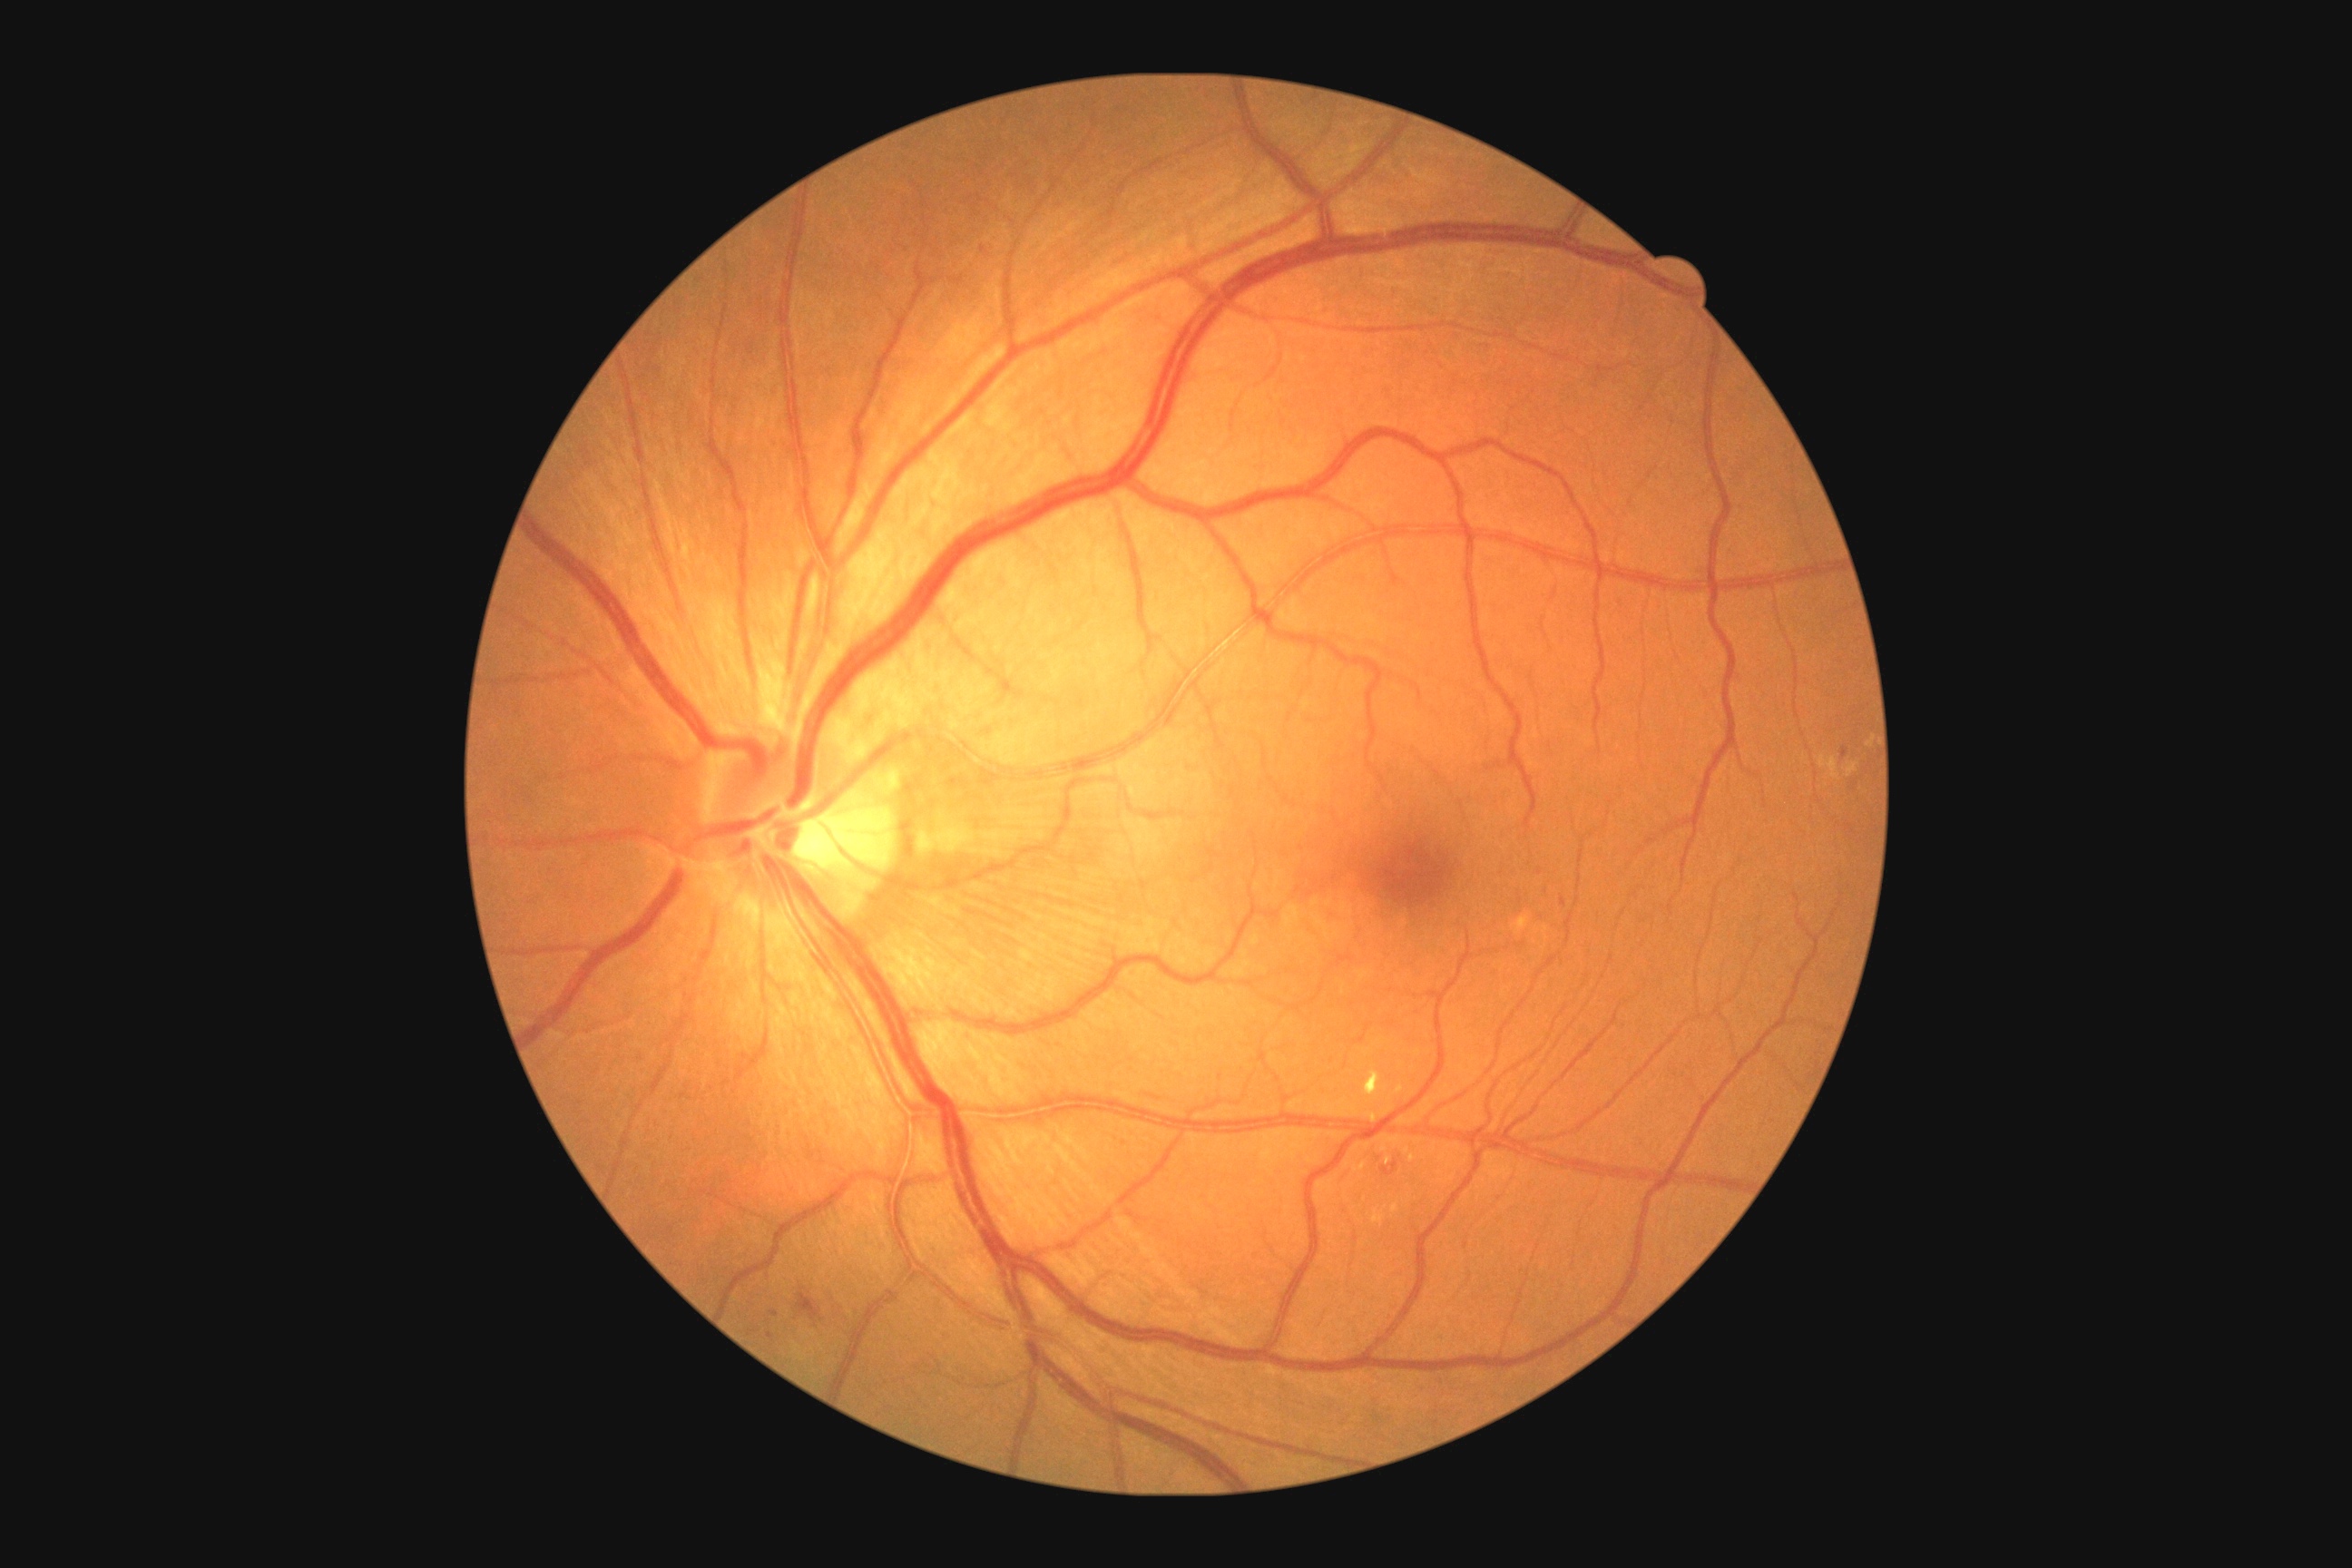

DR: moderate non-proliferative diabetic retinopathy (grade 2). EXs are present, including at 1396:1086:1404:1093 | 1373:1210:1386:1226 | 1366:1112:1378:1124 | 1391:1204:1398:1213 | 1377:1135:1402:1153 | 1364:1068:1386:1099. Smaller EXs around x=1412 y=1158 | x=1388 y=1160 | x=1406 y=1151. No SEs identified. MAs are present, including at 1476:514:1482:524 | 1560:897:1567:908 | 770:1311:779:1317 | 1841:747:1848:760 | 750:1329:760:1335. Smaller MAs around x=771 y=1336 | x=983 y=249. HEs located at 796:1293:823:1322 | 1380:1161:1398:1177.